Mydriatic (tropicamide and phenylephrine)
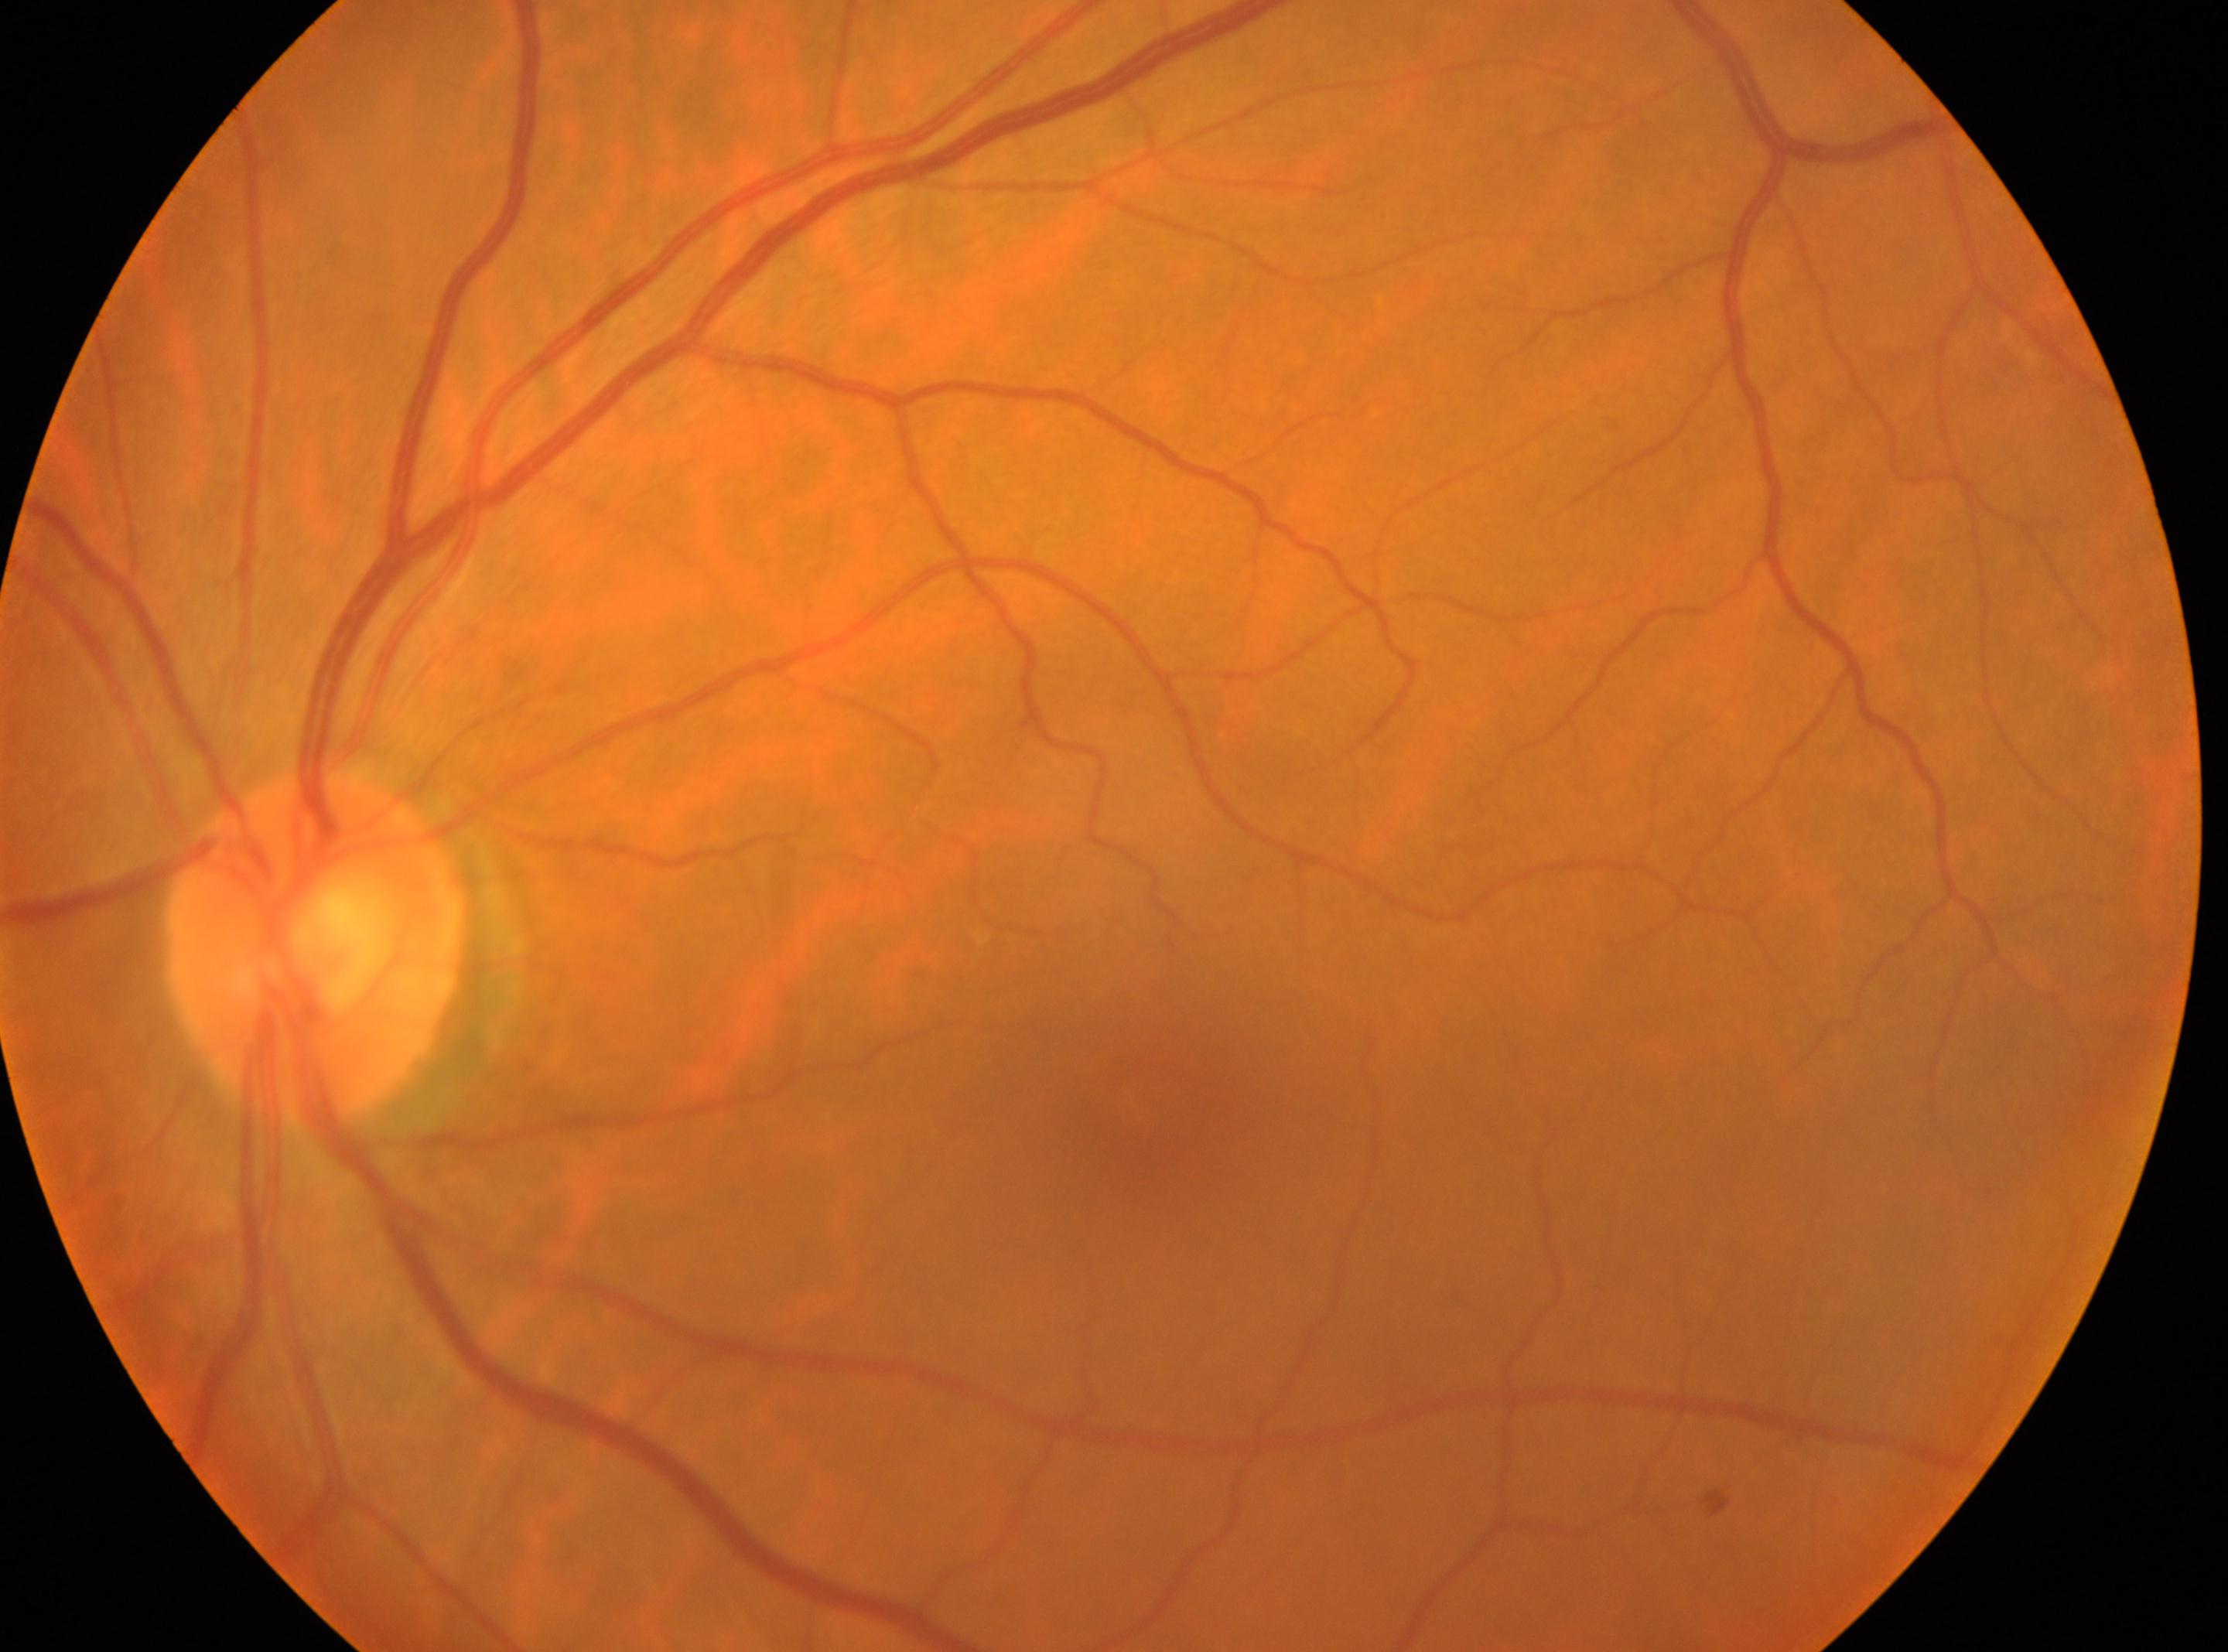
Q: Right or left eye?
A: the left eye
Q: Locate the fovea.
A: x=1142, y=1104
Q: Optic disc center?
A: x=320, y=947
Q: Any diabetic retinopathy?
A: No diabetic retinopathy identified
Q: DR stage?
A: grade 0 (no apparent retinopathy)